45-degree field of view — 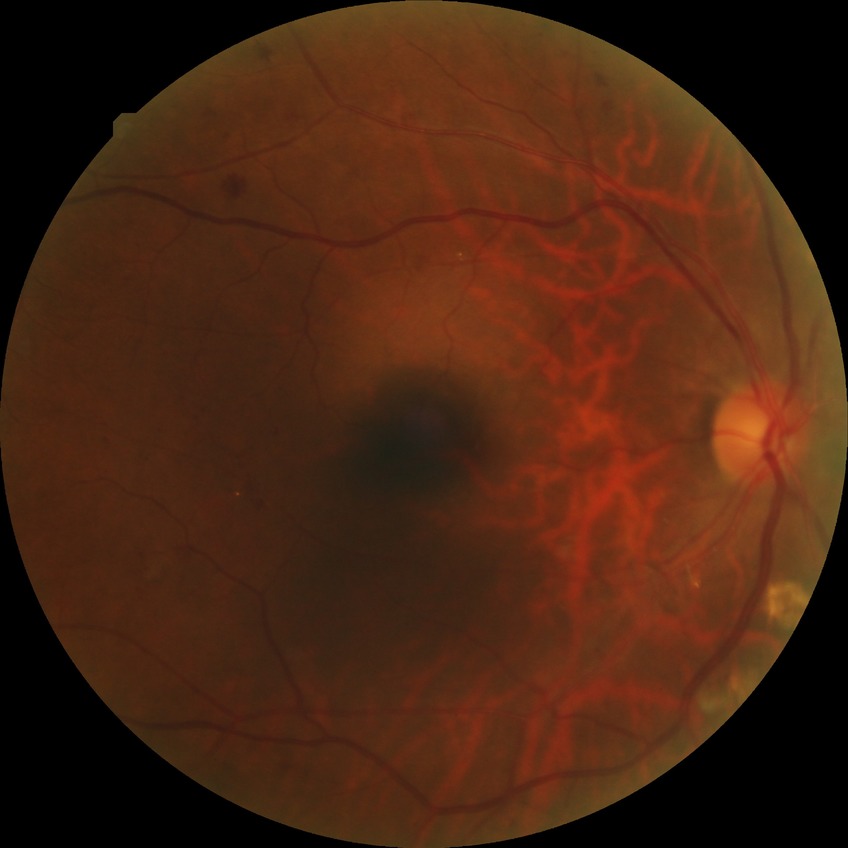 Diabetic retinopathy (DR): proliferative diabetic retinopathy (PDR).